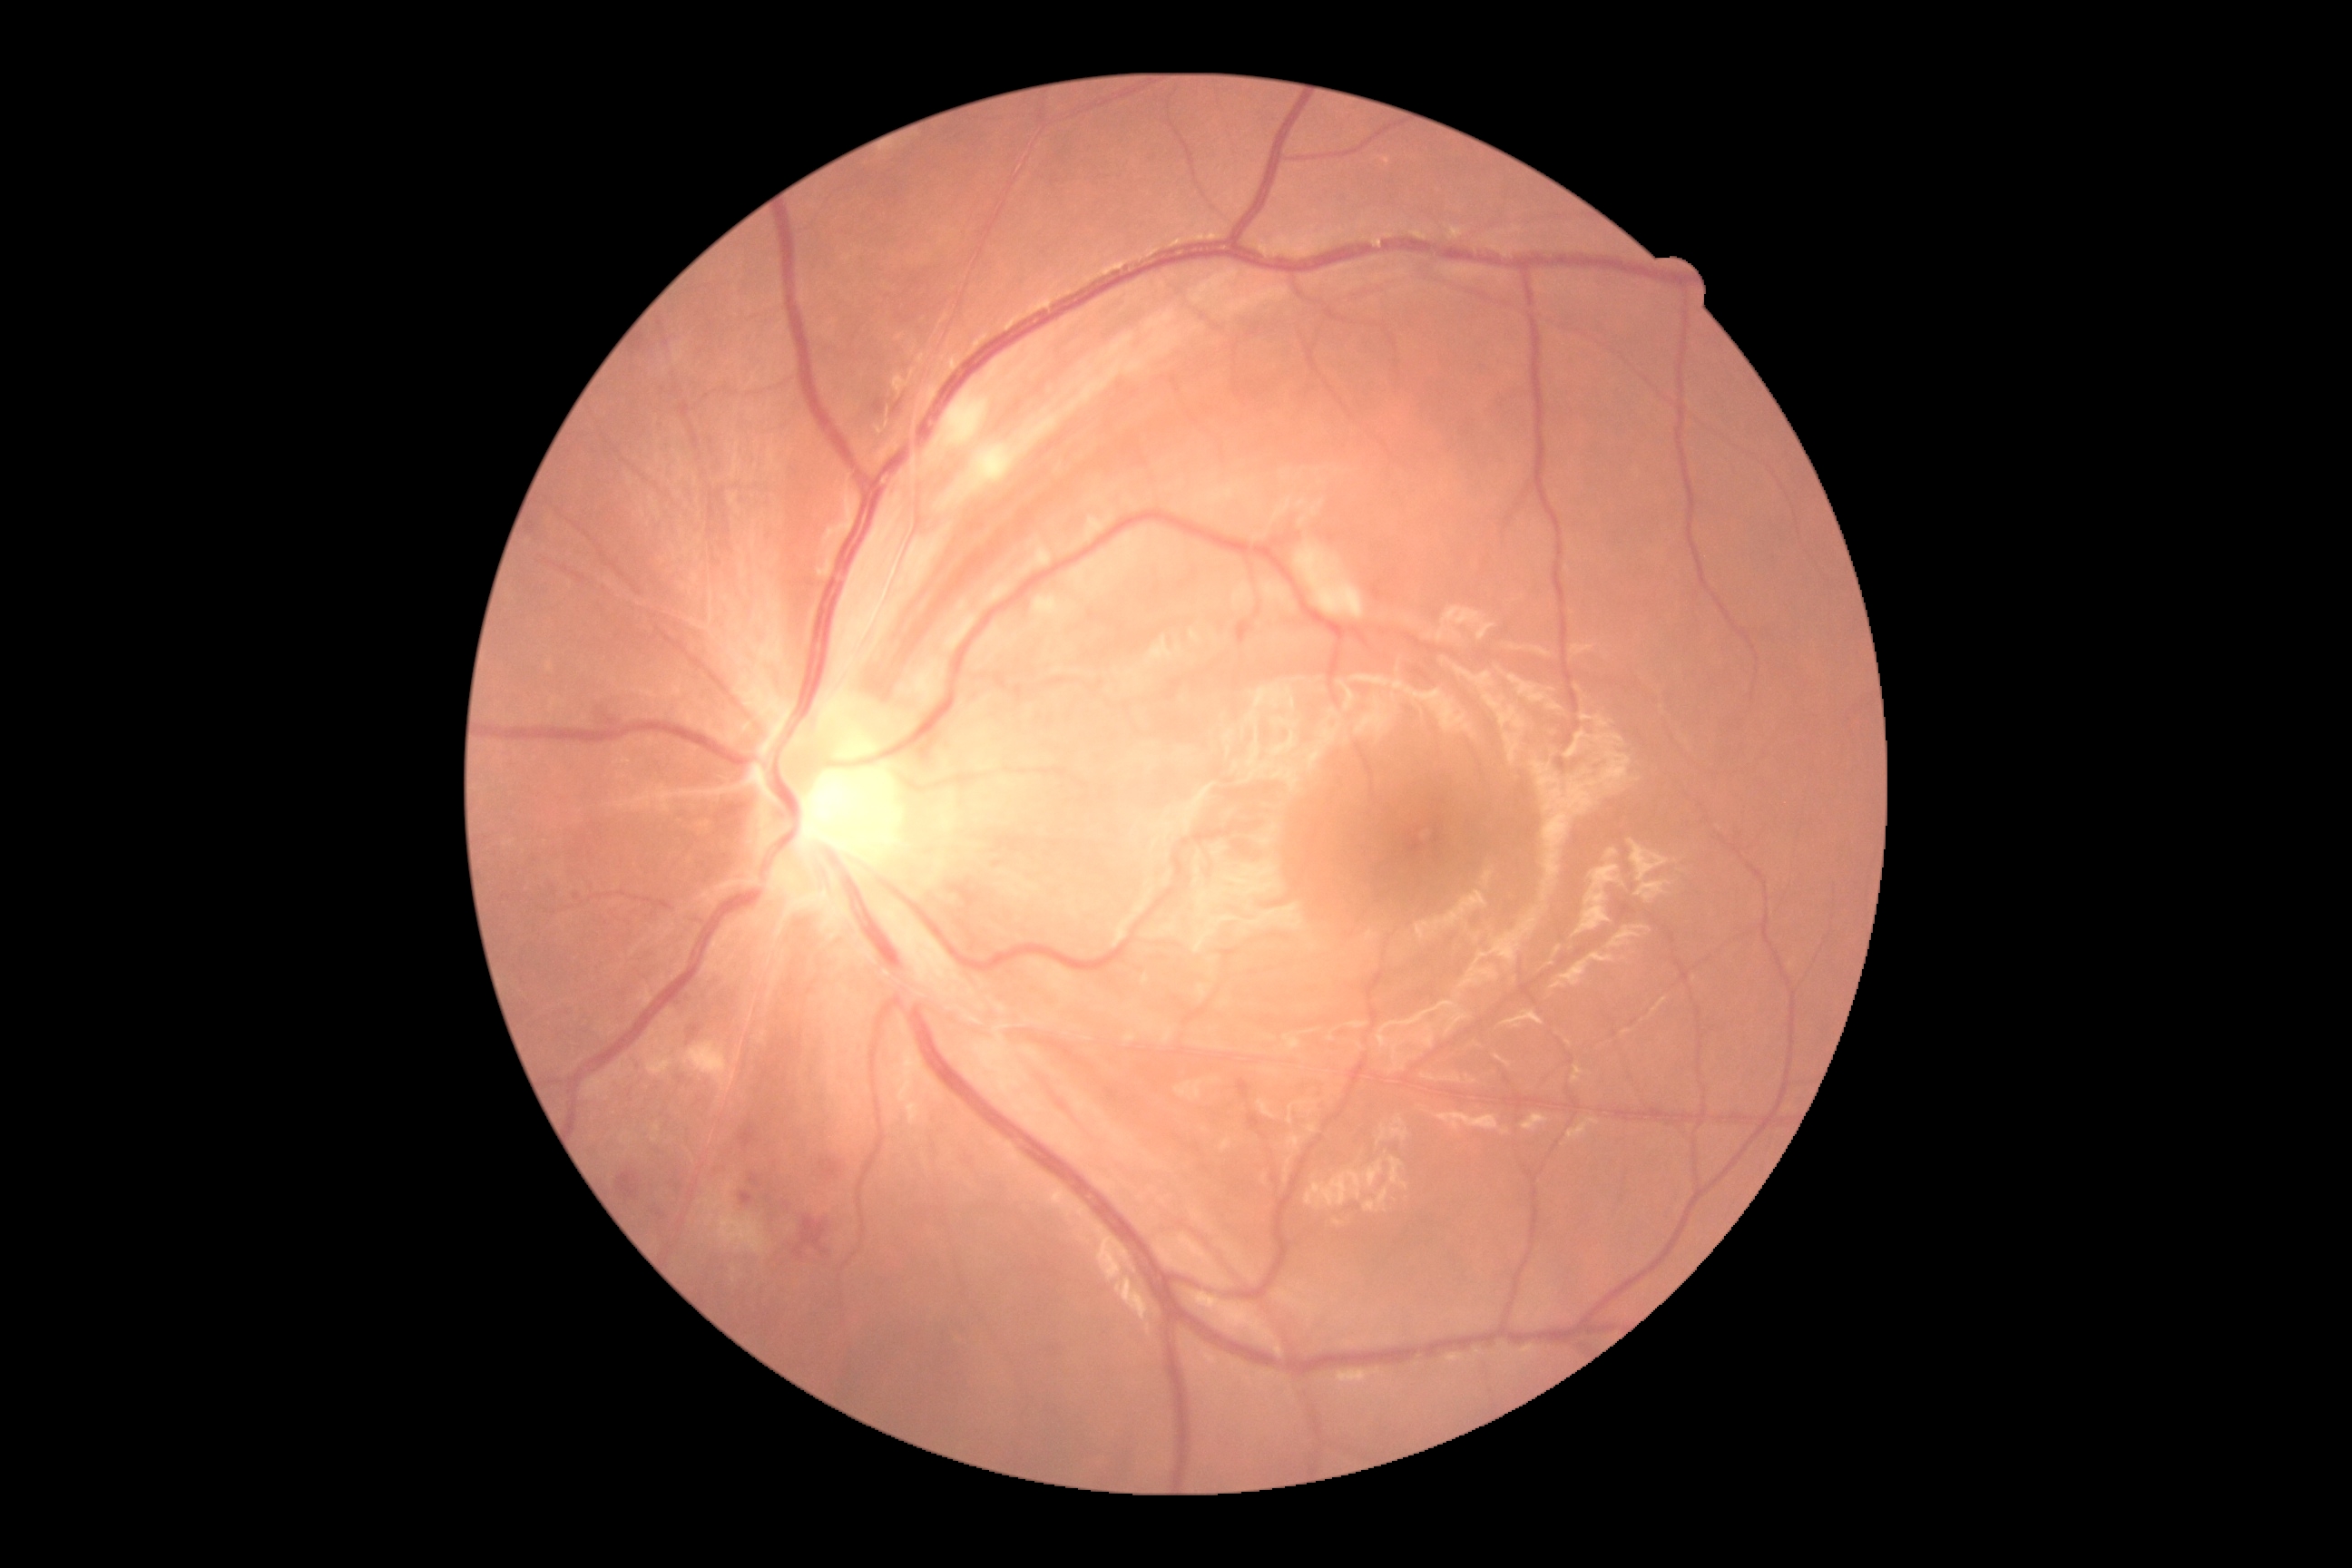 Findings:
• retinopathy grade — 2